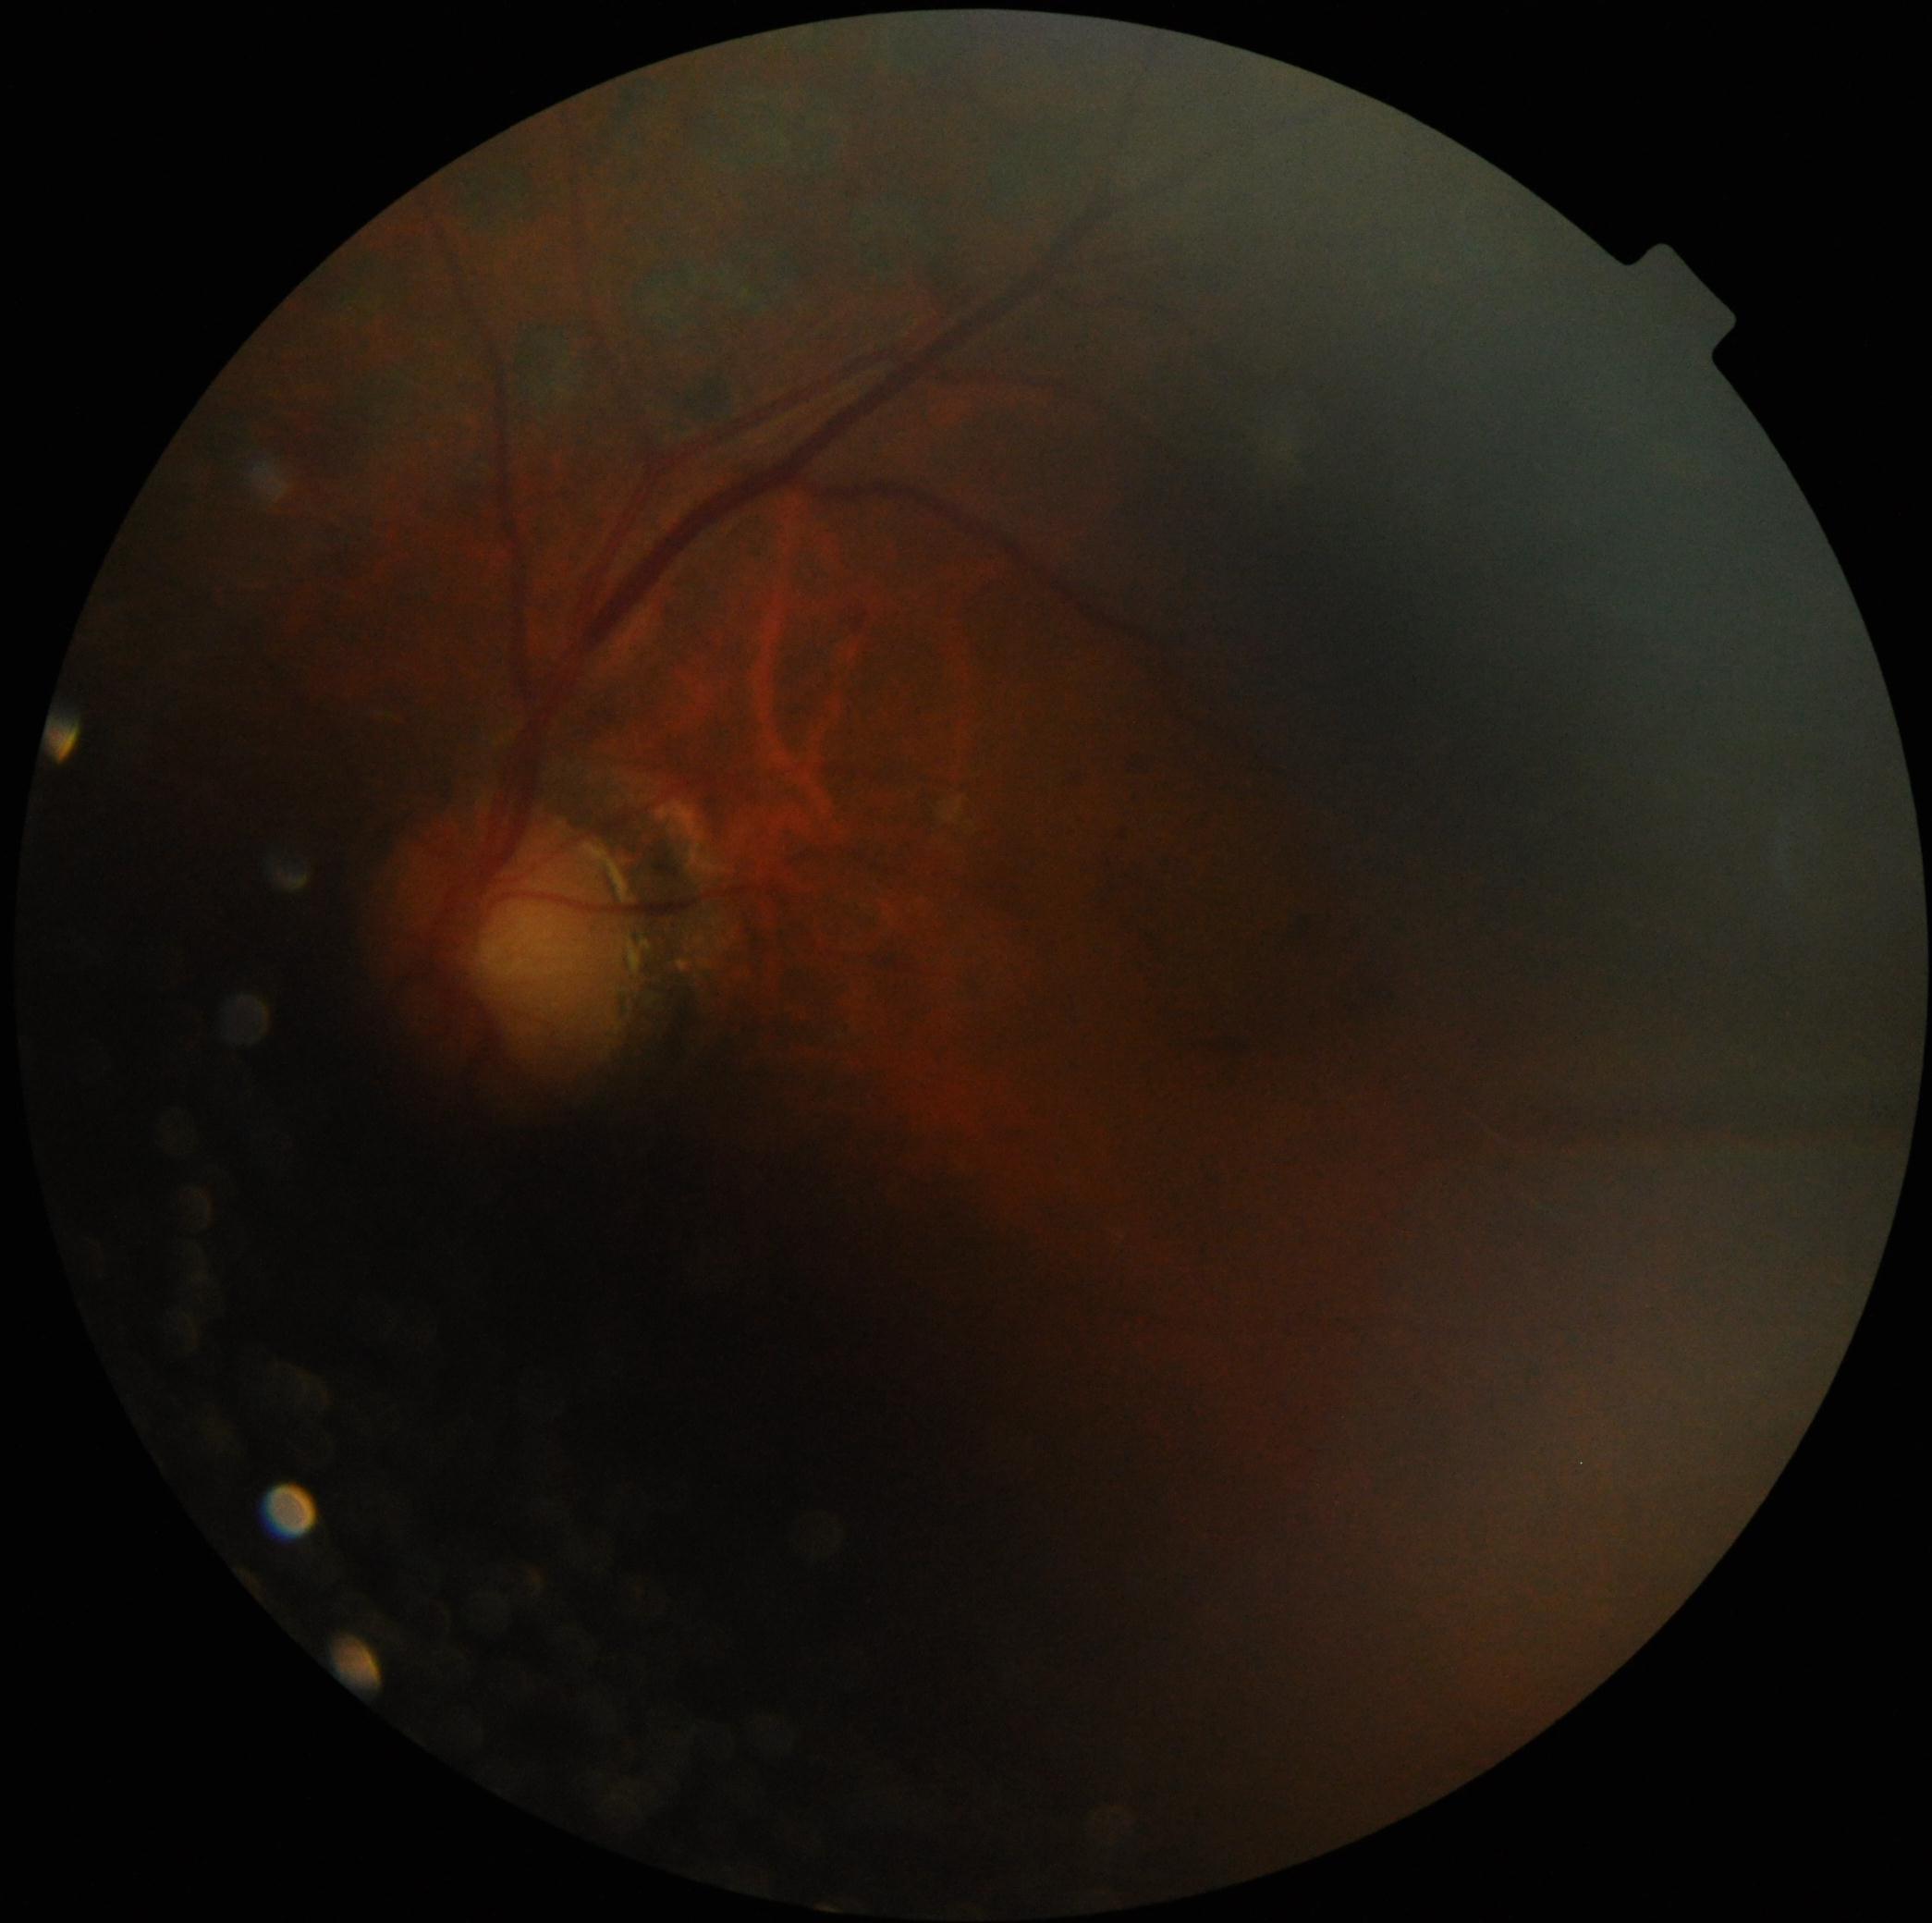
DR class: non-proliferative diabetic retinopathy.
Diabetic retinopathy (DR): grade 2 (moderate NPDR).